Wide-field fundus photograph from neonatal ROP screening; acquired on the Clarity RetCam 3:
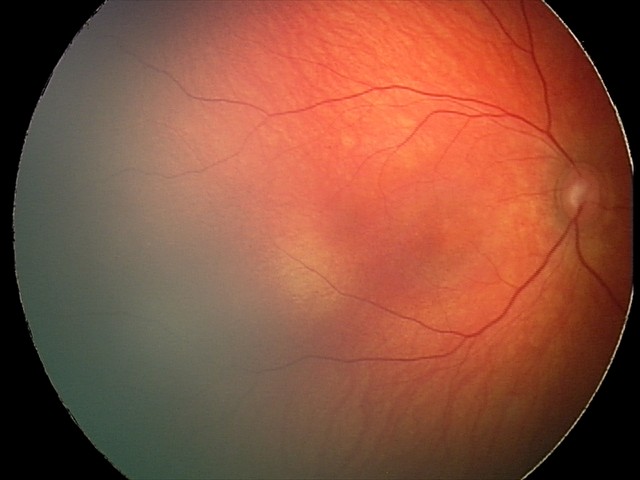

Q: What was the screening finding?
A: retinal hemorrhages